Color fundus image, captured on a Forus 3Nethra Classic.
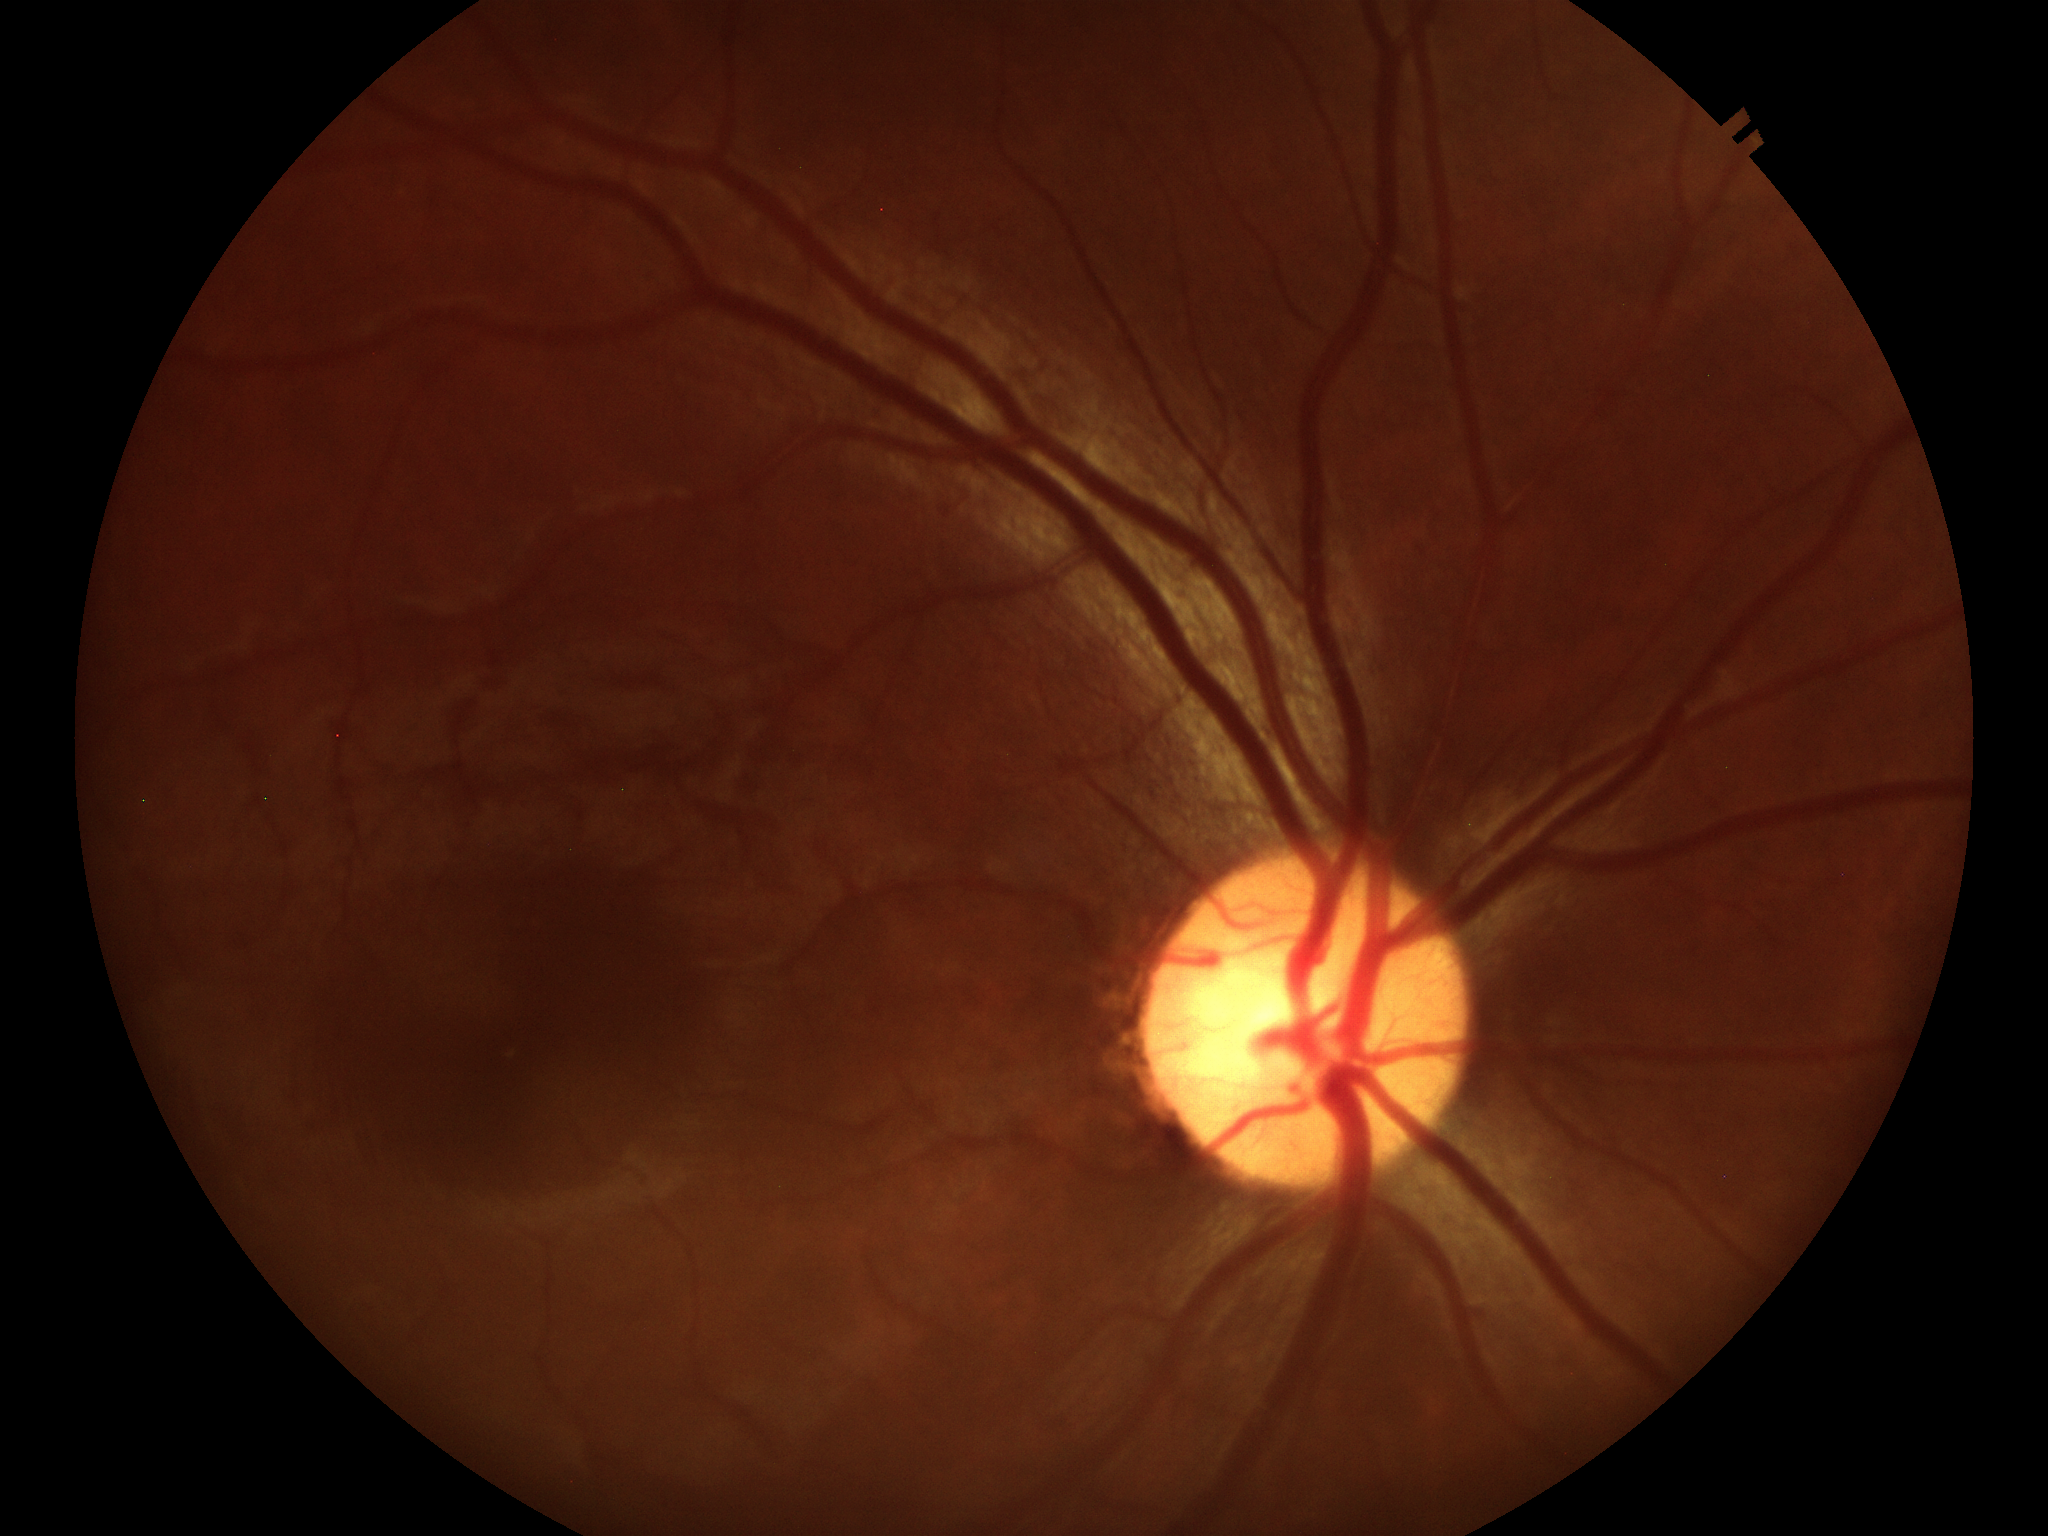

vertical C/D ratio: 0.53 | Glaucoma screening: no suspicious findings